Captured with the Phoenix ICON (100° field of view). Wide-field contact fundus photograph of an infant
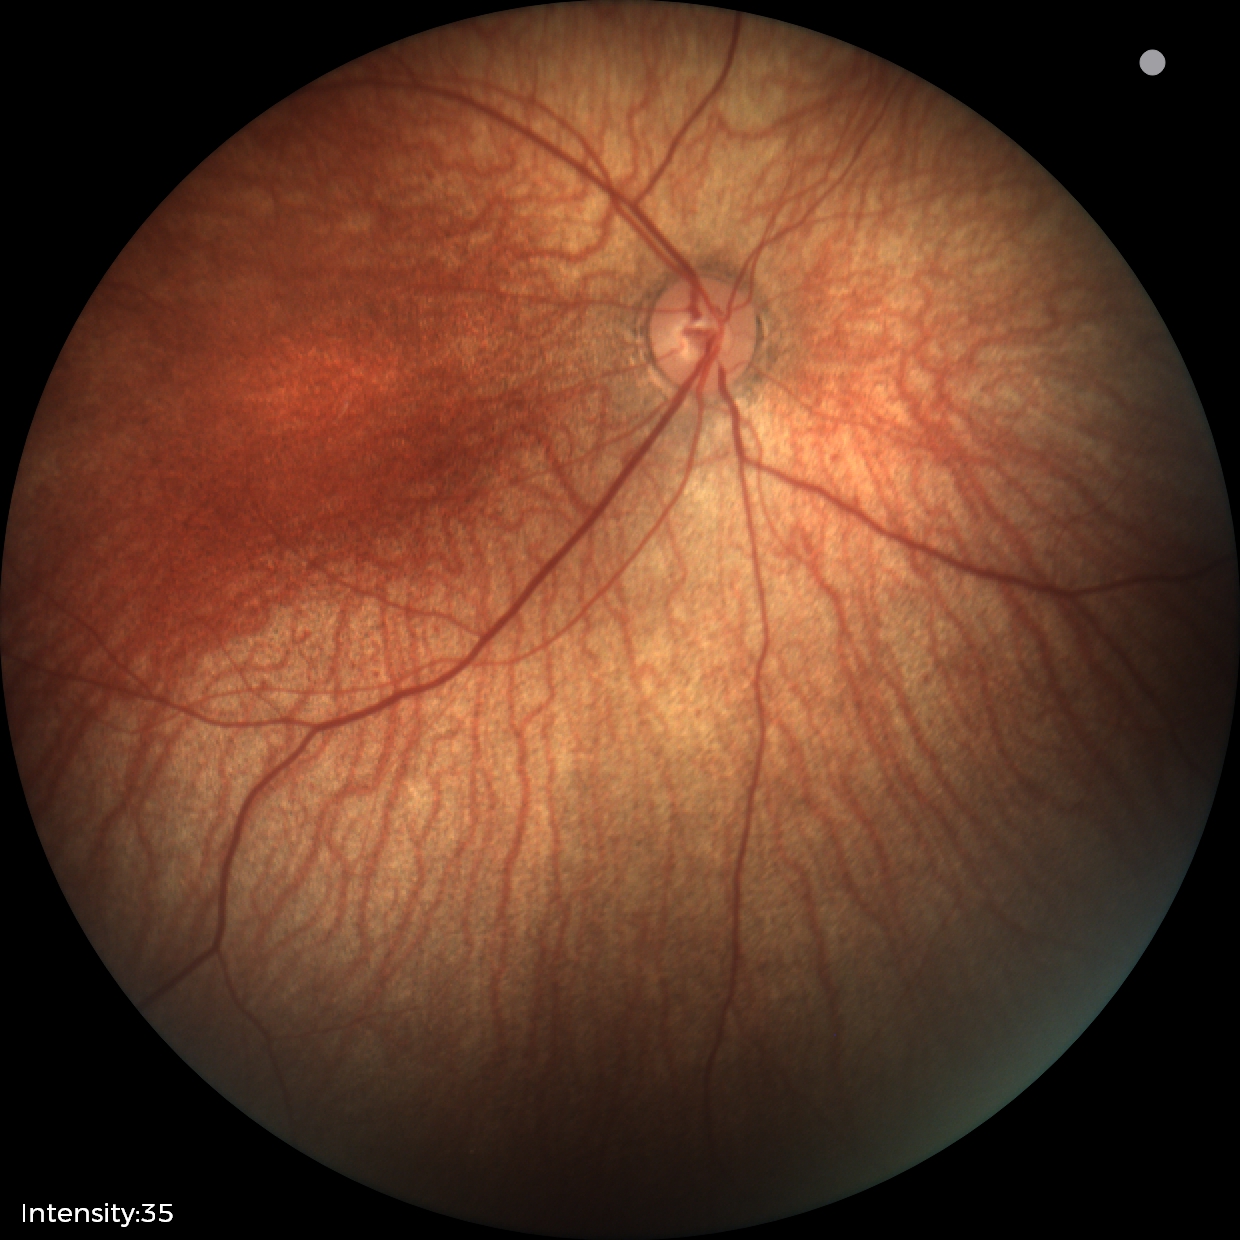 Screening: physiological appearance with no retinal pathology.